Wide-field fundus photograph of an infant; 130° field of view (Natus RetCam Envision): 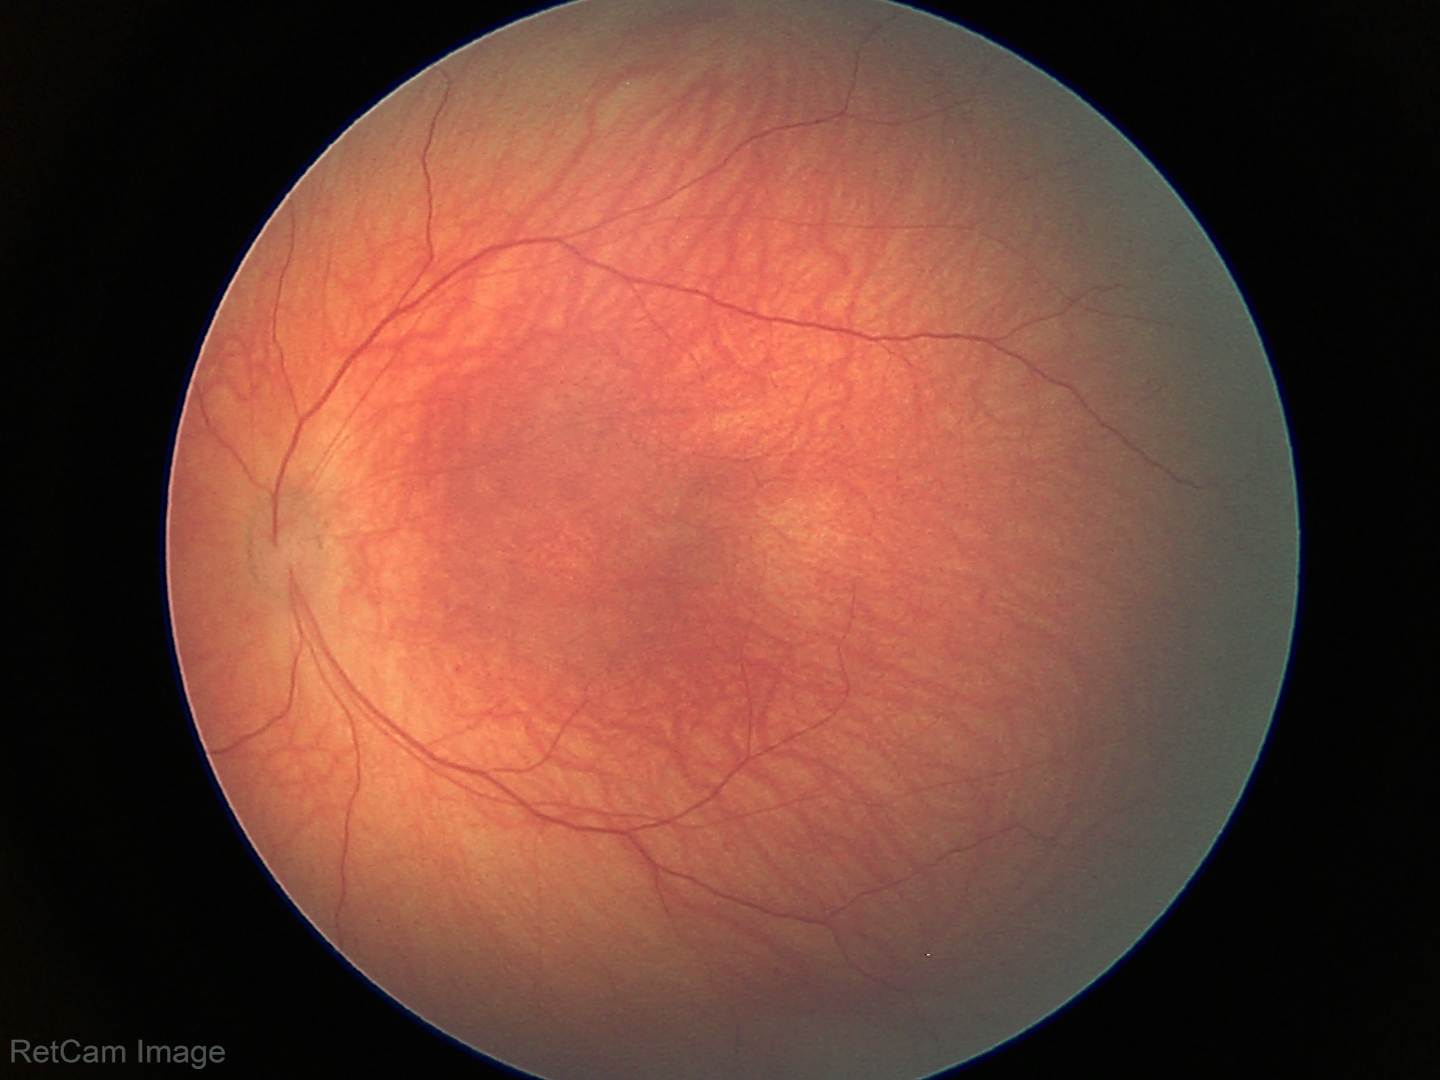
Screening examination diagnosed as physiological.